DR severity per modified Davis staging; nonmydriatic fundus photograph — 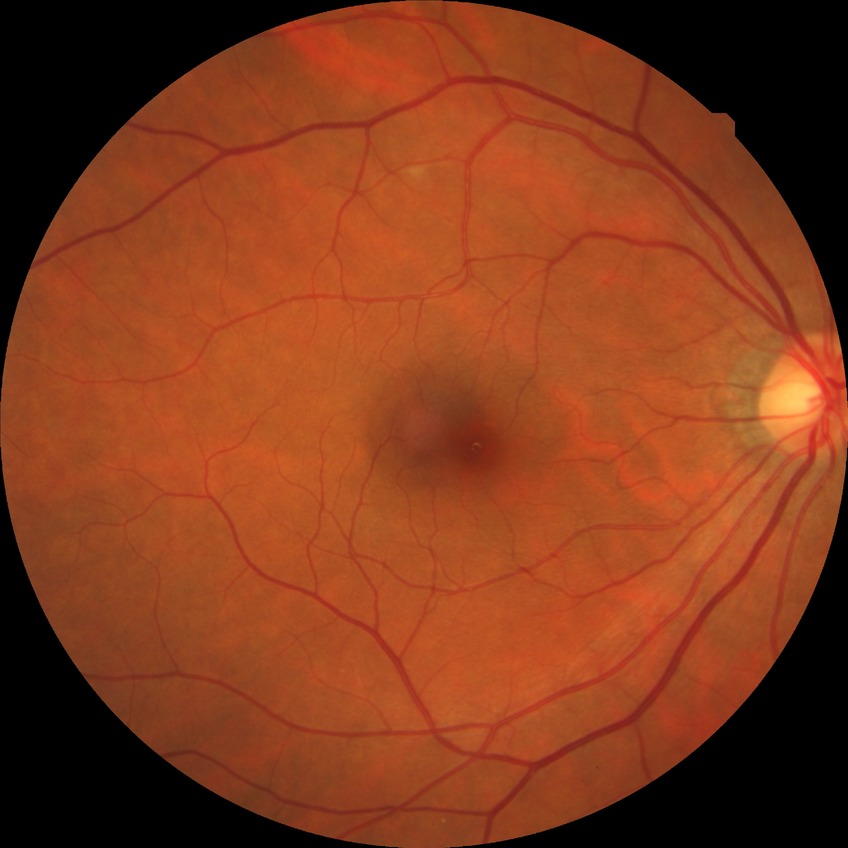

DR grade is NDR.